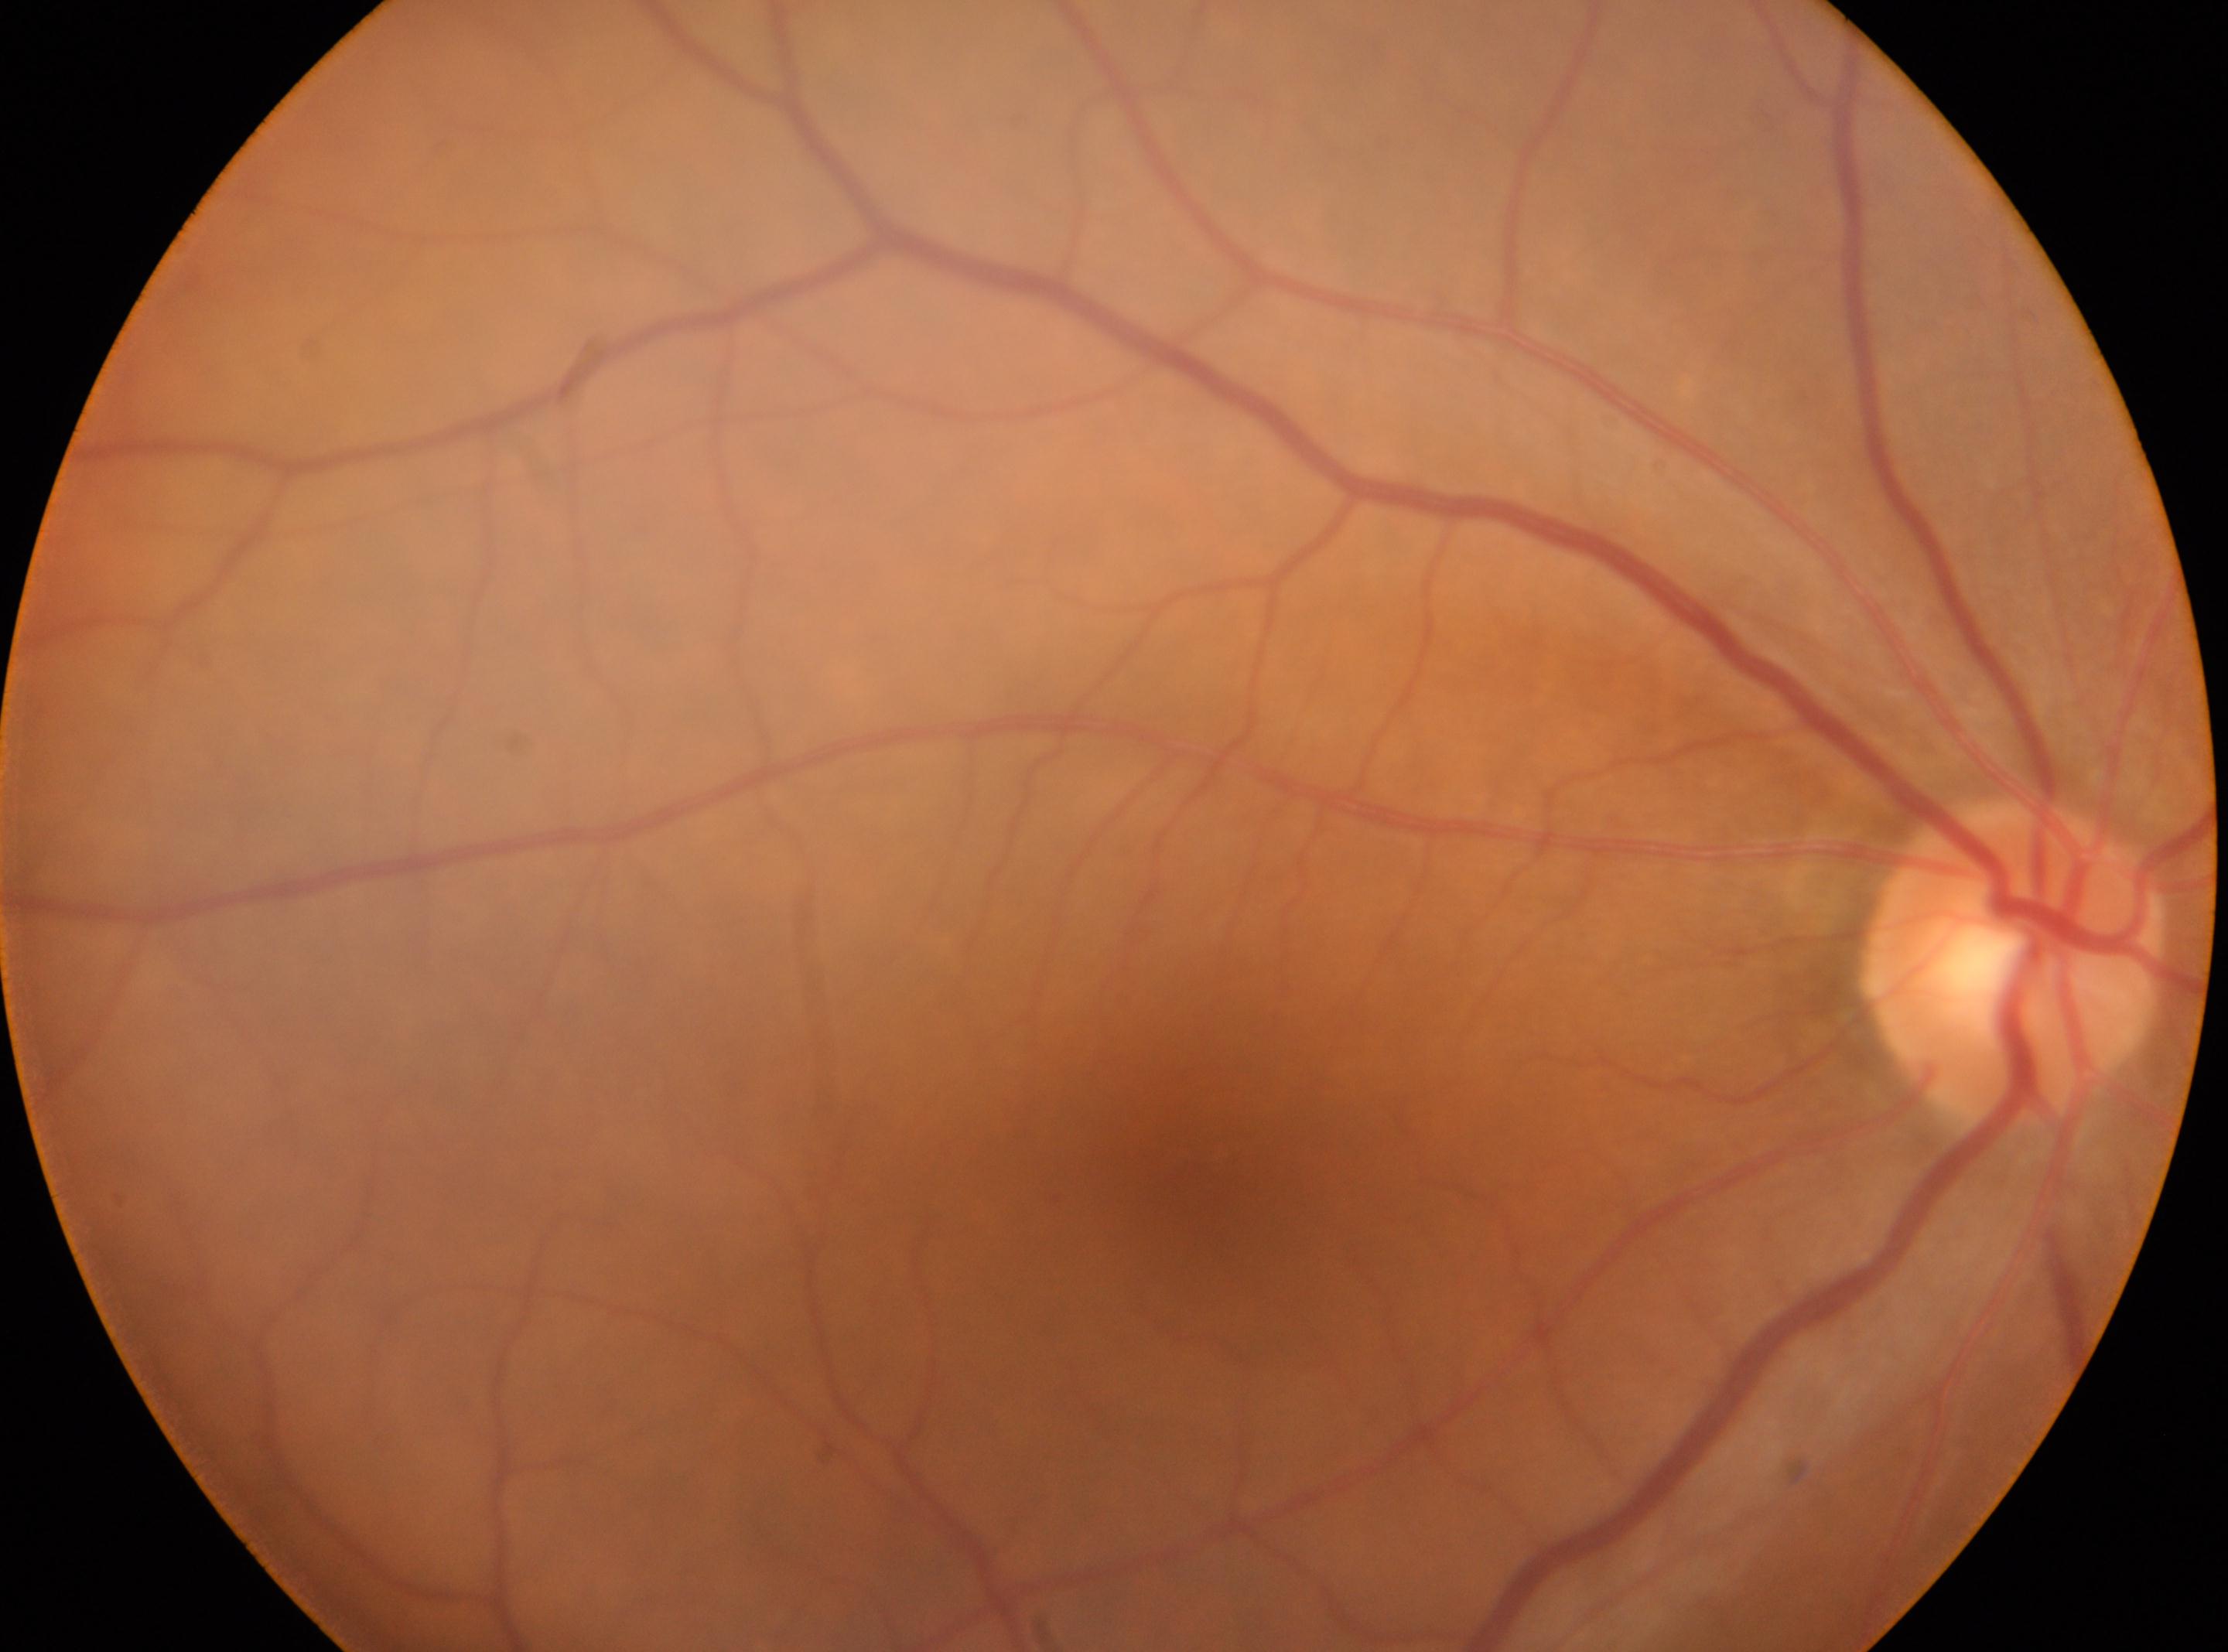

Annotations:
- optic disk: (2013, 959)
- DR: grade 0 (no apparent retinopathy)
- eye: OD
- the fovea: (1211, 1172)